130° field of view (Clarity RetCam 3) · infant wide-field retinal image:
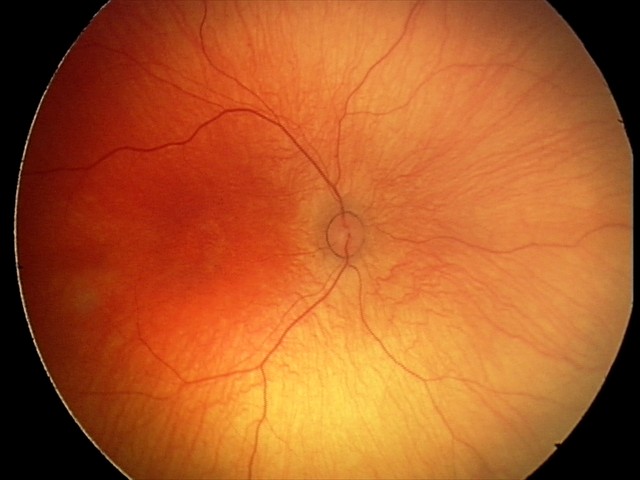

Screening examination with no abnormal retinal findings.